Davis DR grading; 848x848; CFP: 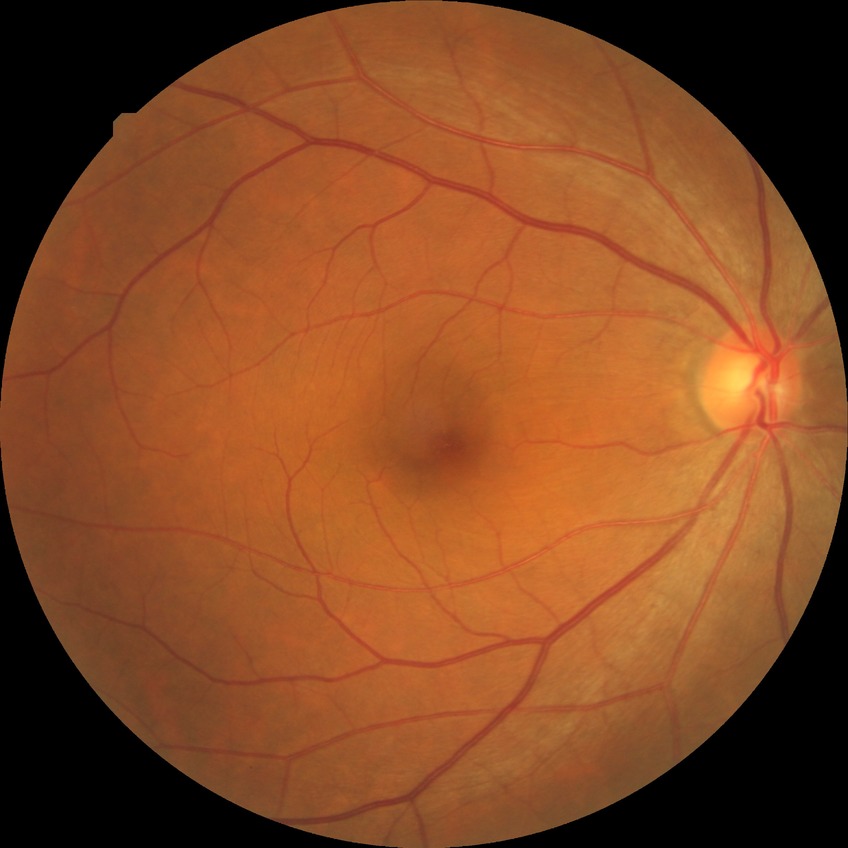
Diabetic retinopathy (DR) is NDR (no diabetic retinopathy).